848 by 848 pixels. Fundus photo: 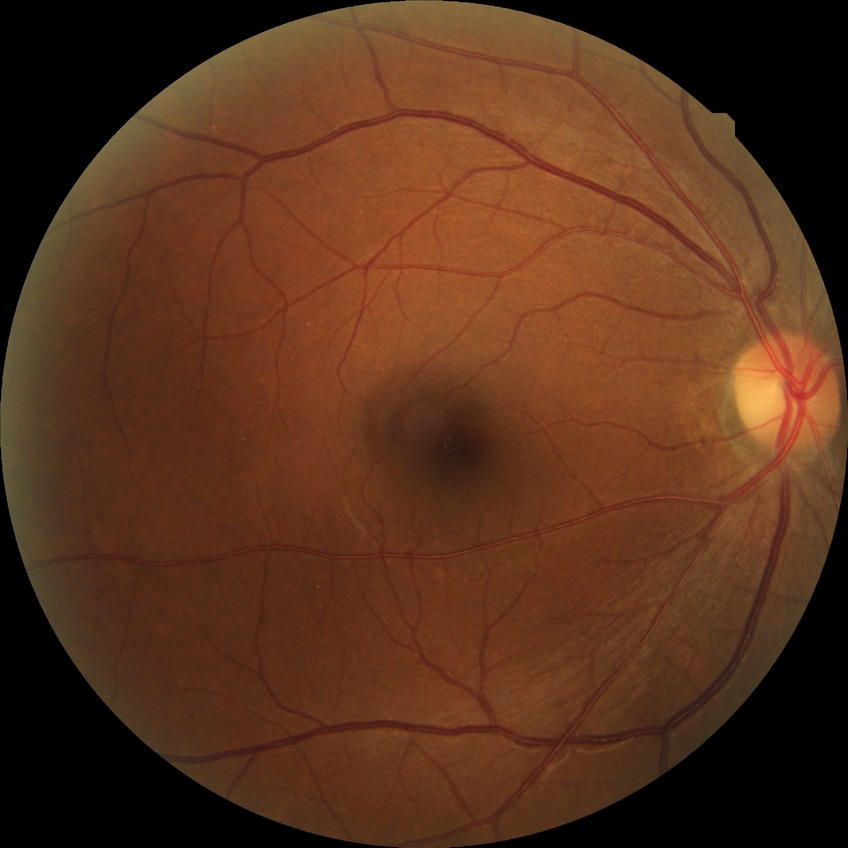

diabetic retinopathy (DR)@NDR (no diabetic retinopathy).